848x848 · modified Davis classification.
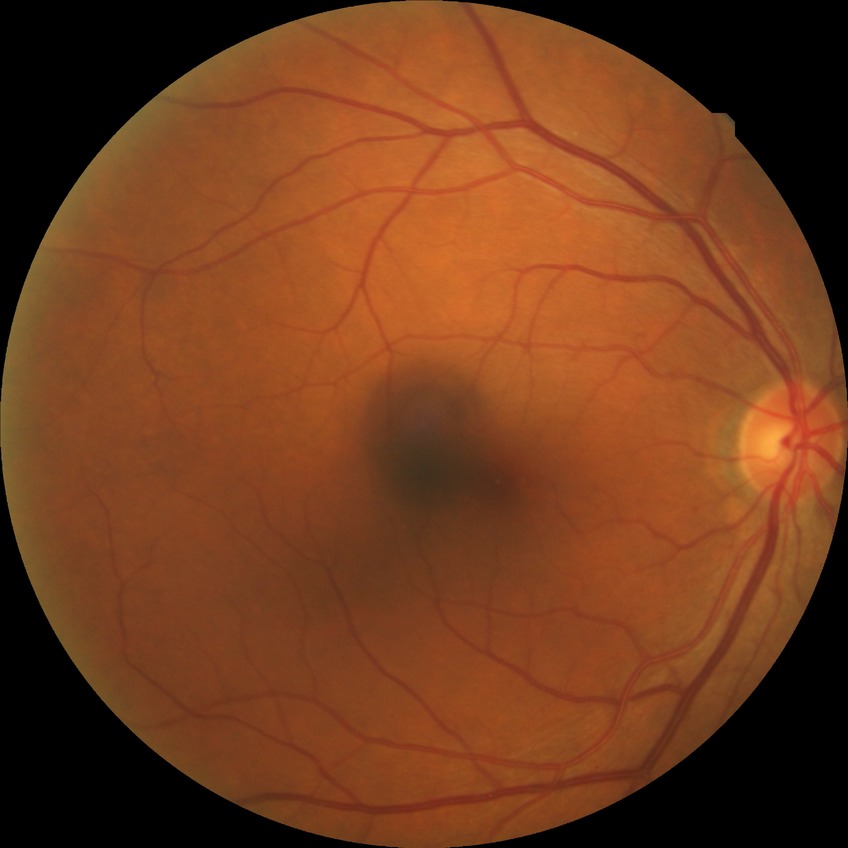 modified Davis grading: no diabetic retinopathy.